45 degree fundus photograph · posterior pole color fundus photograph · no pharmacologic dilation · 848 x 848 pixels: 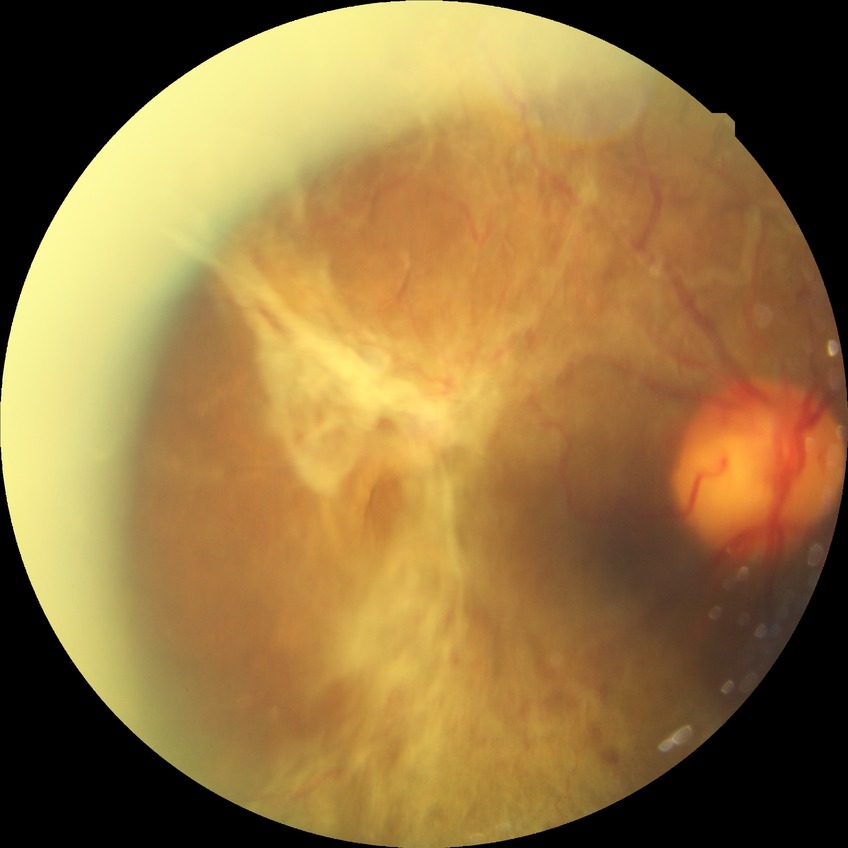

diabetic retinopathy severity=proliferative diabetic retinopathy.